1440x1080. Wide-field contact fundus photograph of an infant — 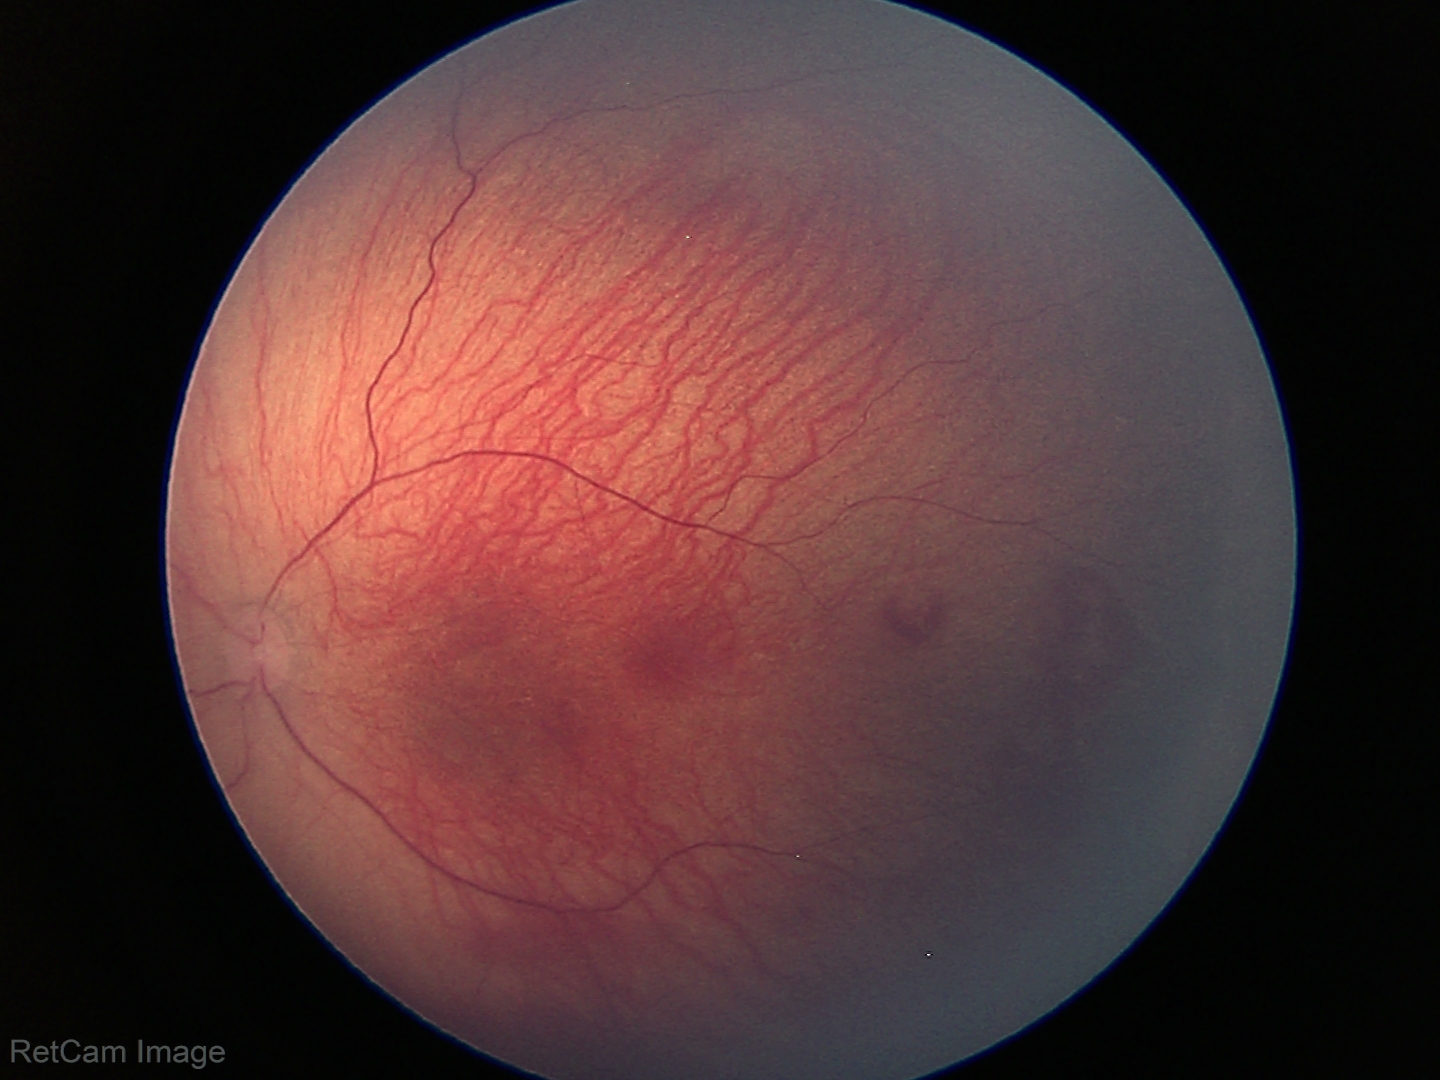 Screening: ROP stage 1.